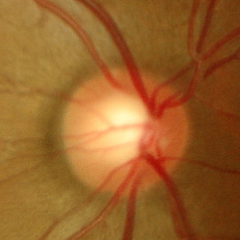 Optic disc photograph demonstrating no evidence of glaucoma.